1440x1080px. Pediatric retinal photograph (wide-field): 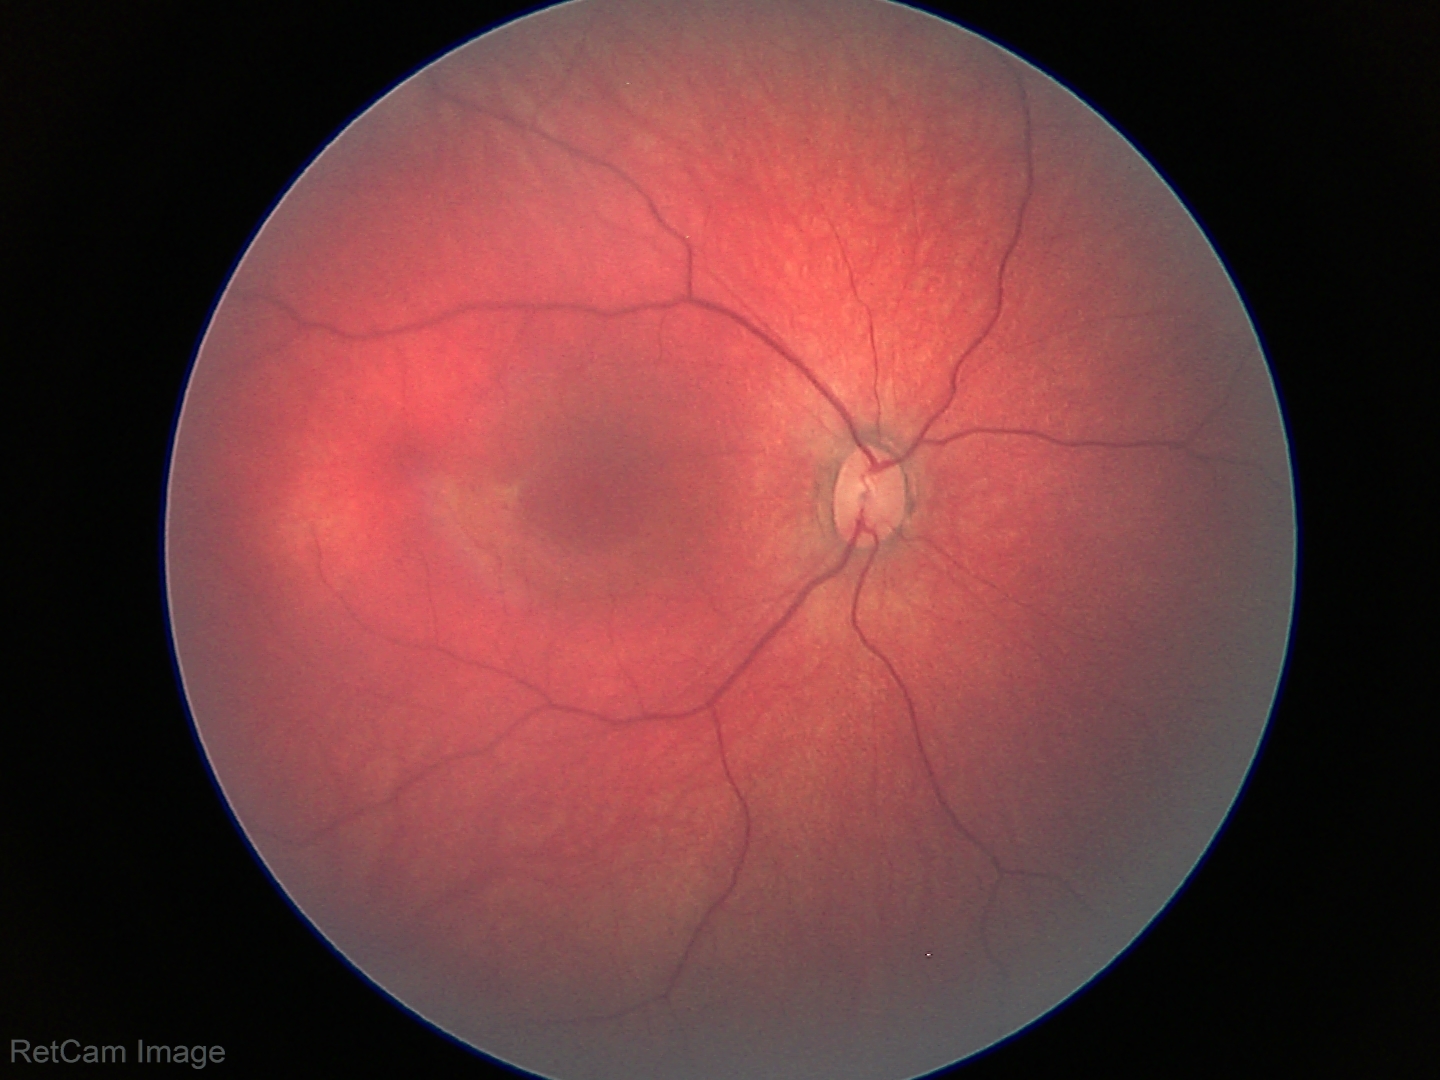
Screening: normal retinal appearance.